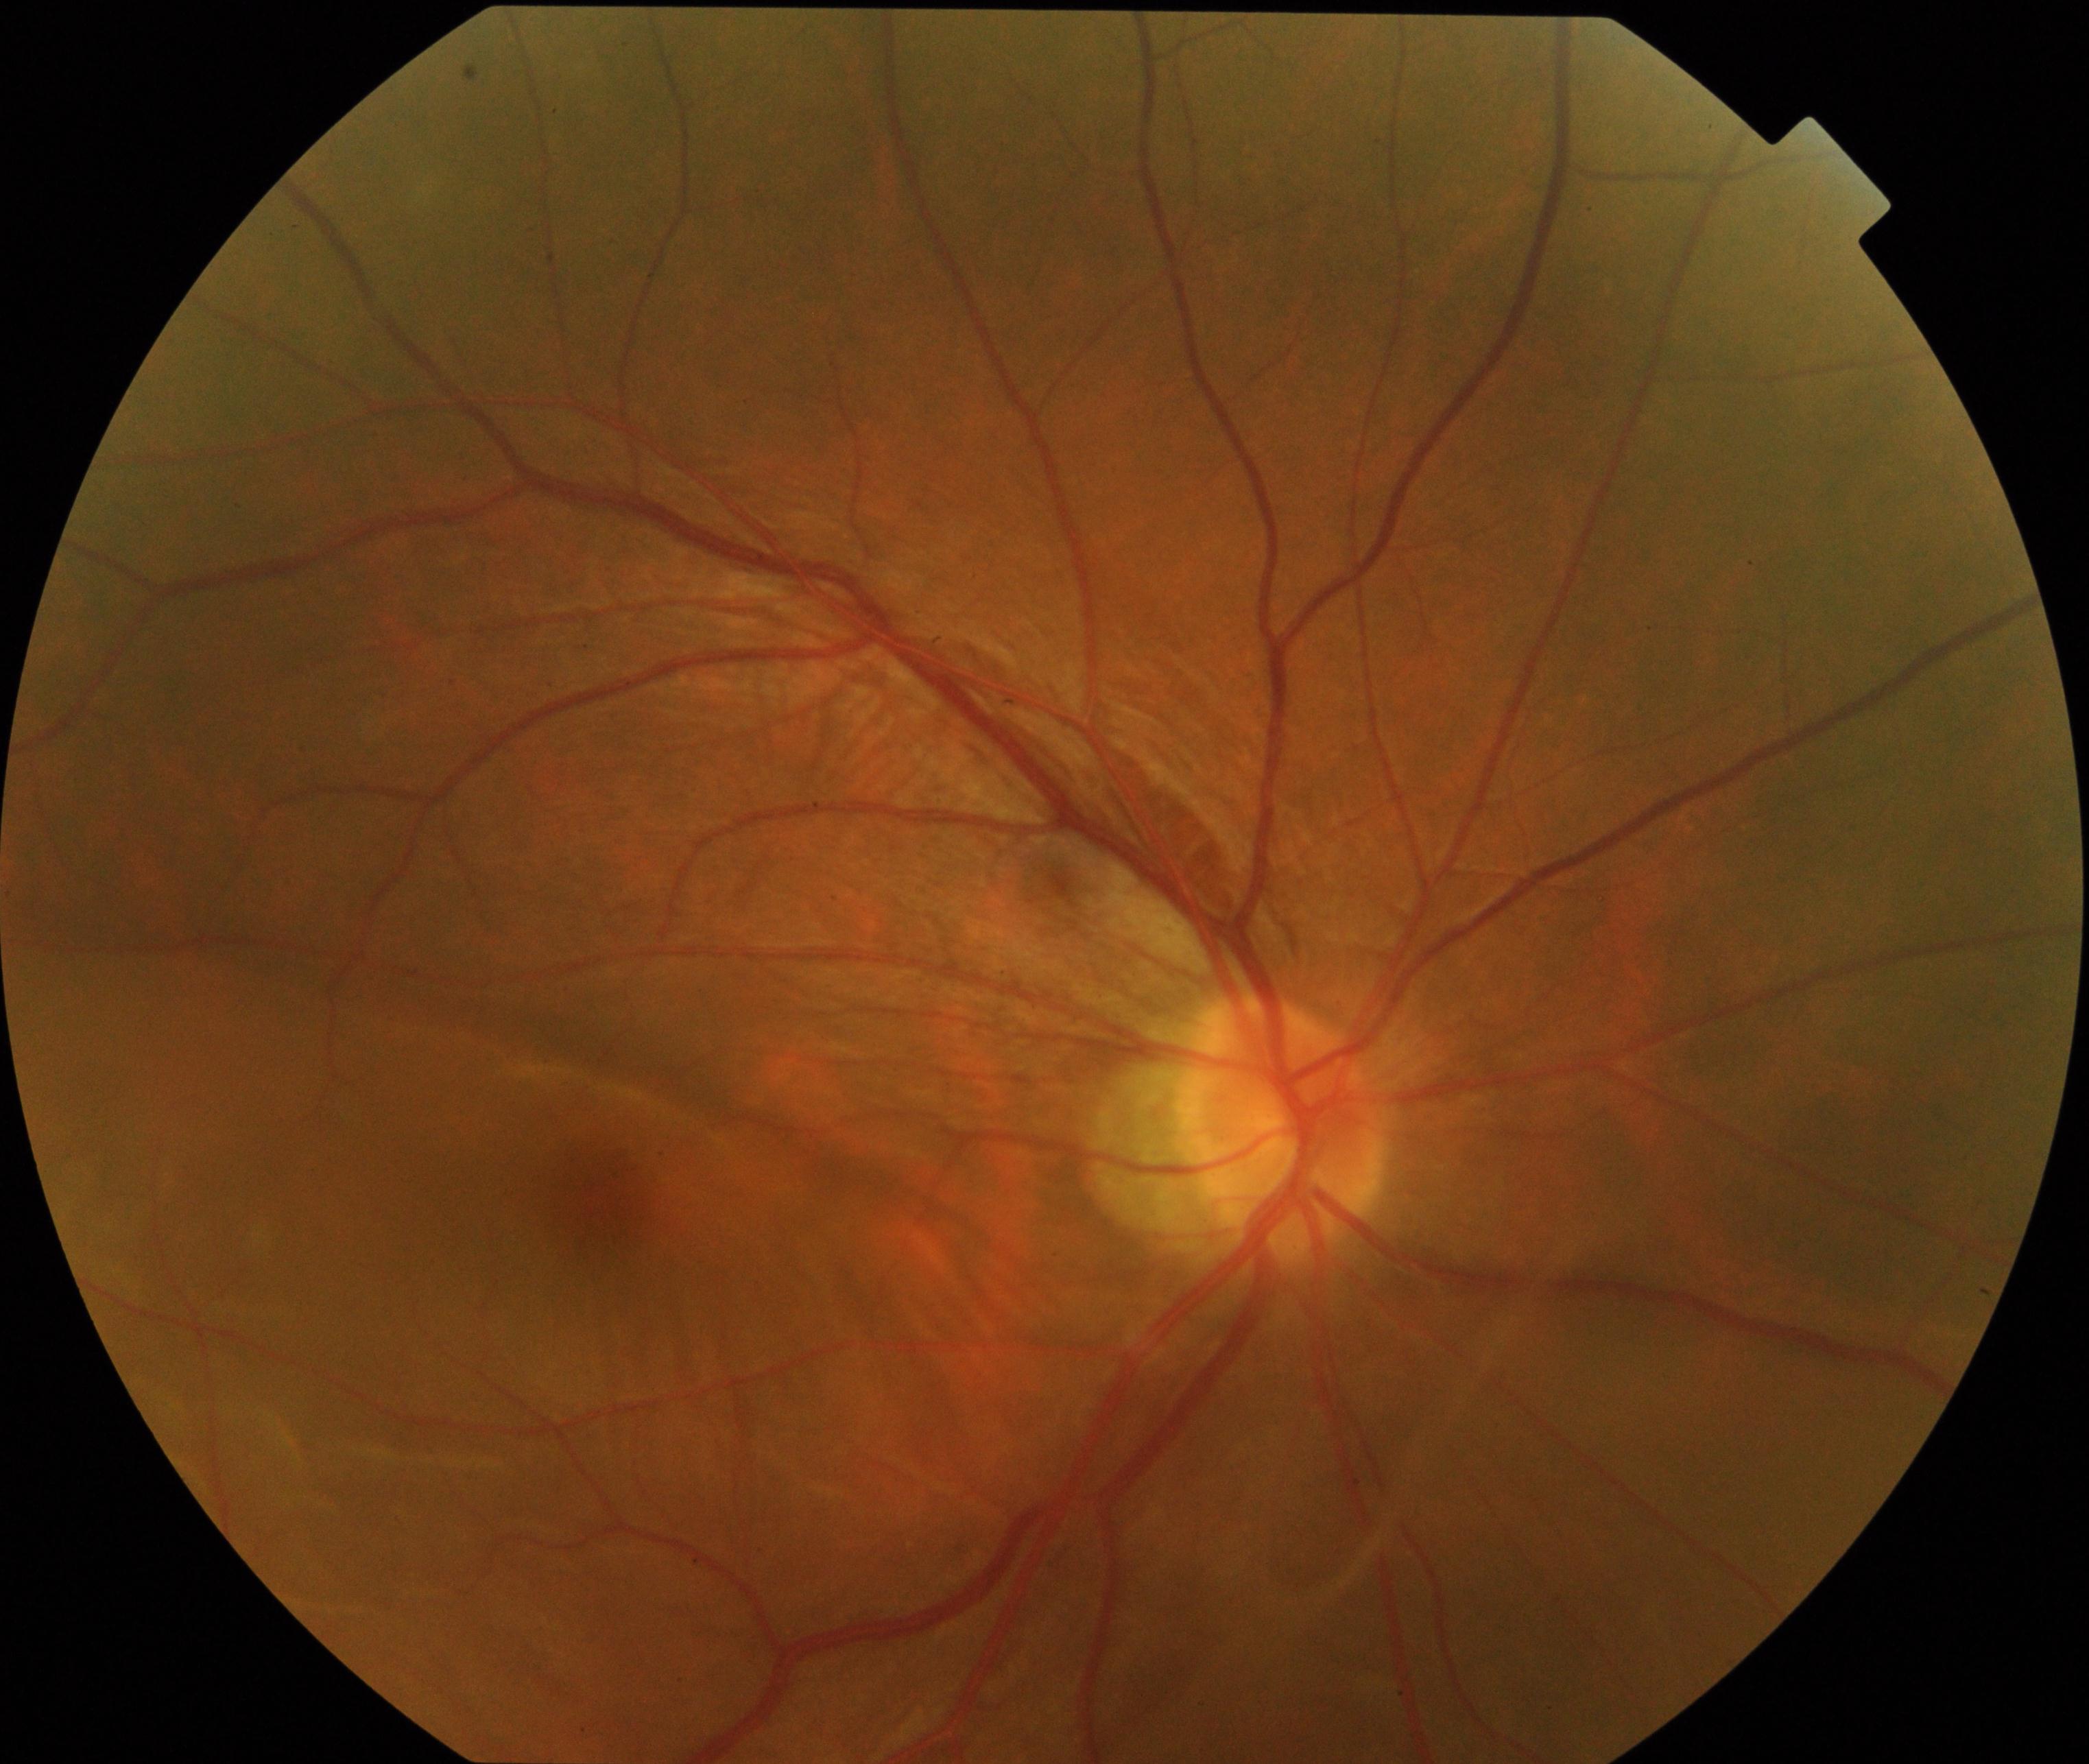

This fundus photograph shows rhegmatogenous retinal detachment. Defined by slightly opaque, convex or corrugated appearance of elevated retina, sometimes with retinal breaks in view.